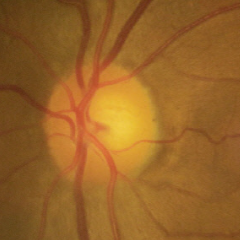 No signs of glaucoma.